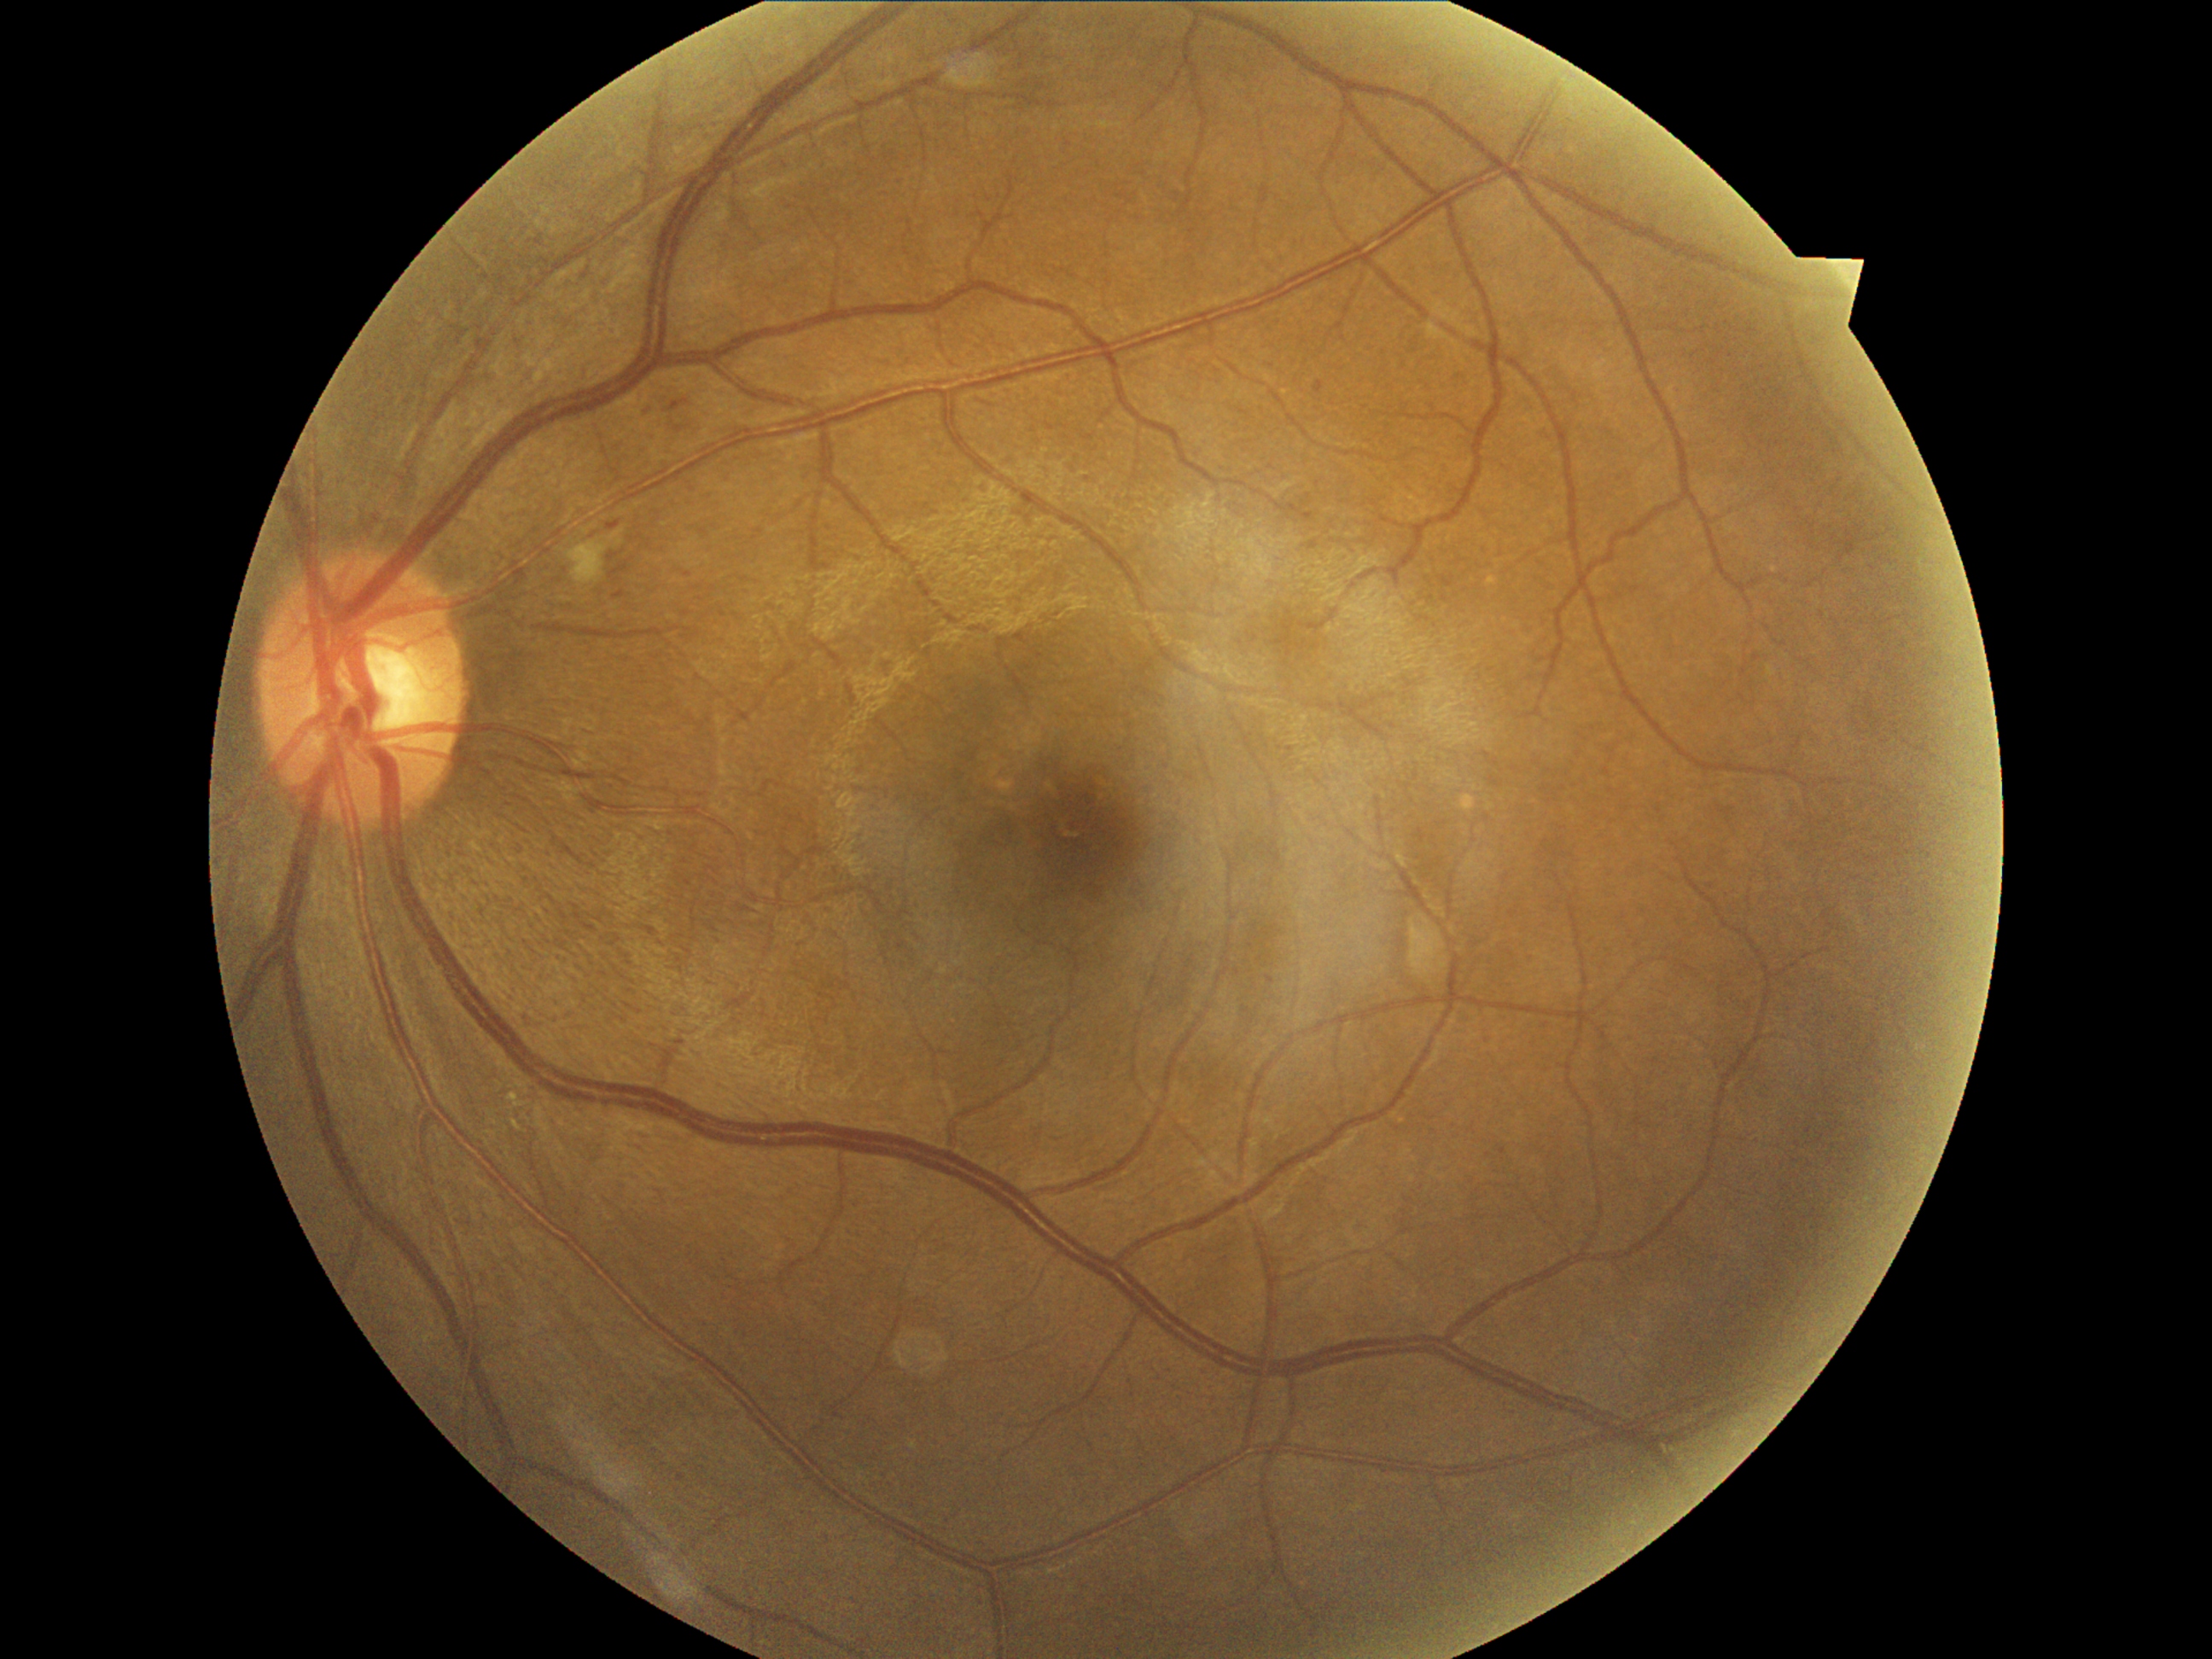
  dr_grade: 2